Infant wide-field retinal image · 1240x1240px:
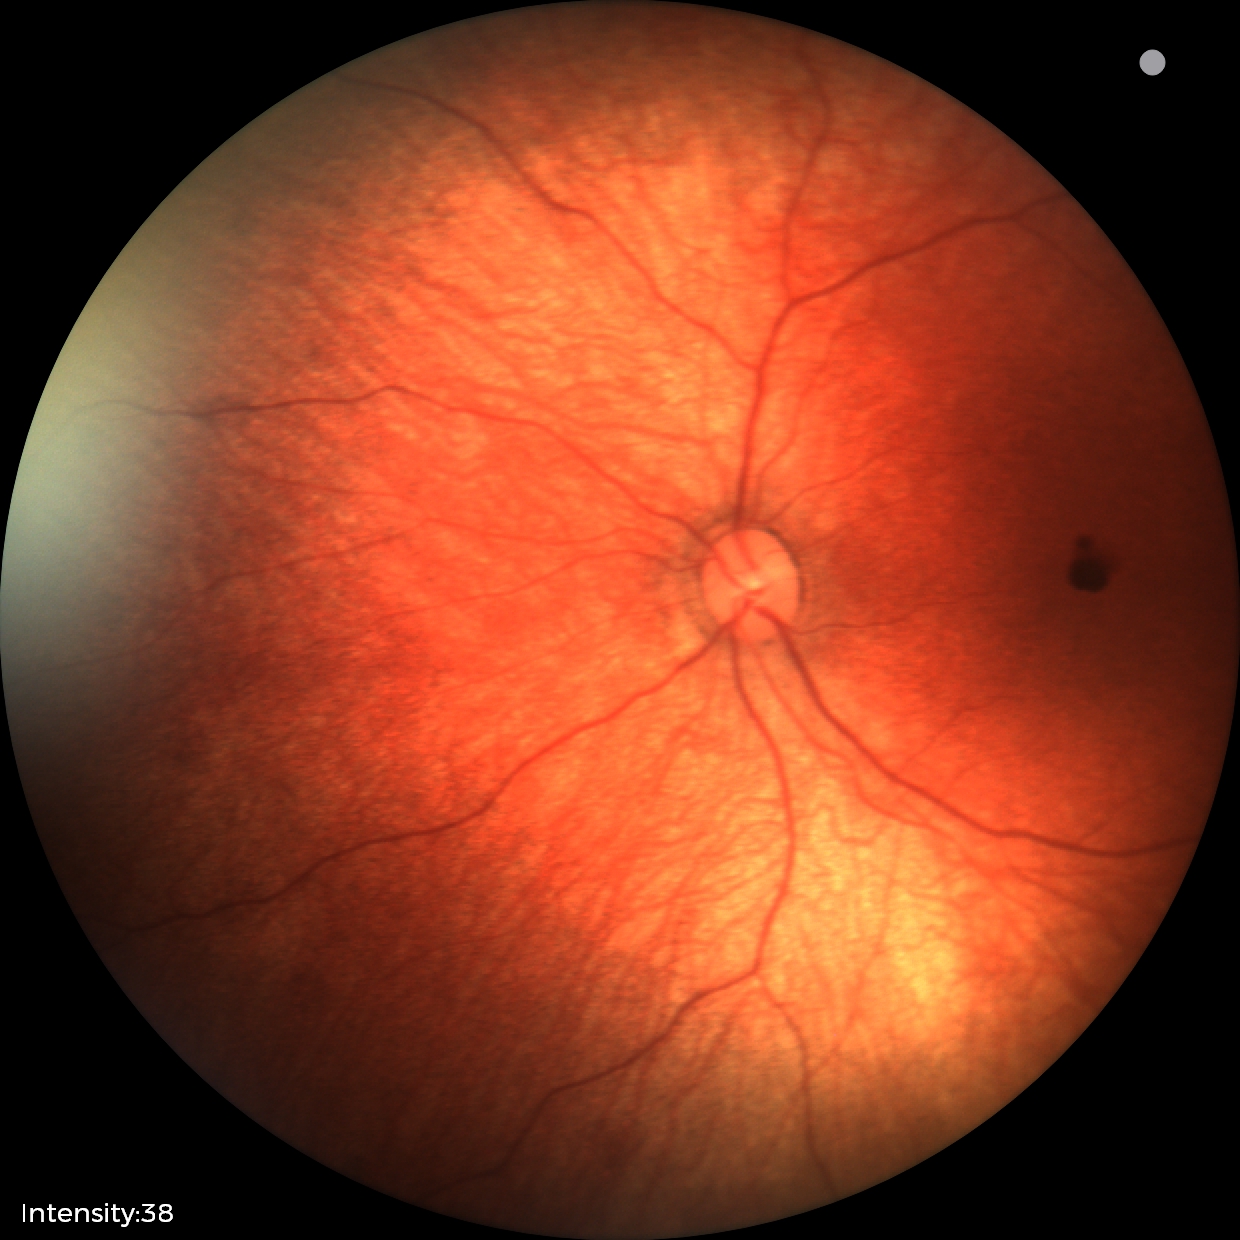
Diagnosis from this screening exam: retinal hemorrhages.